Camera: NIDEK AFC-230
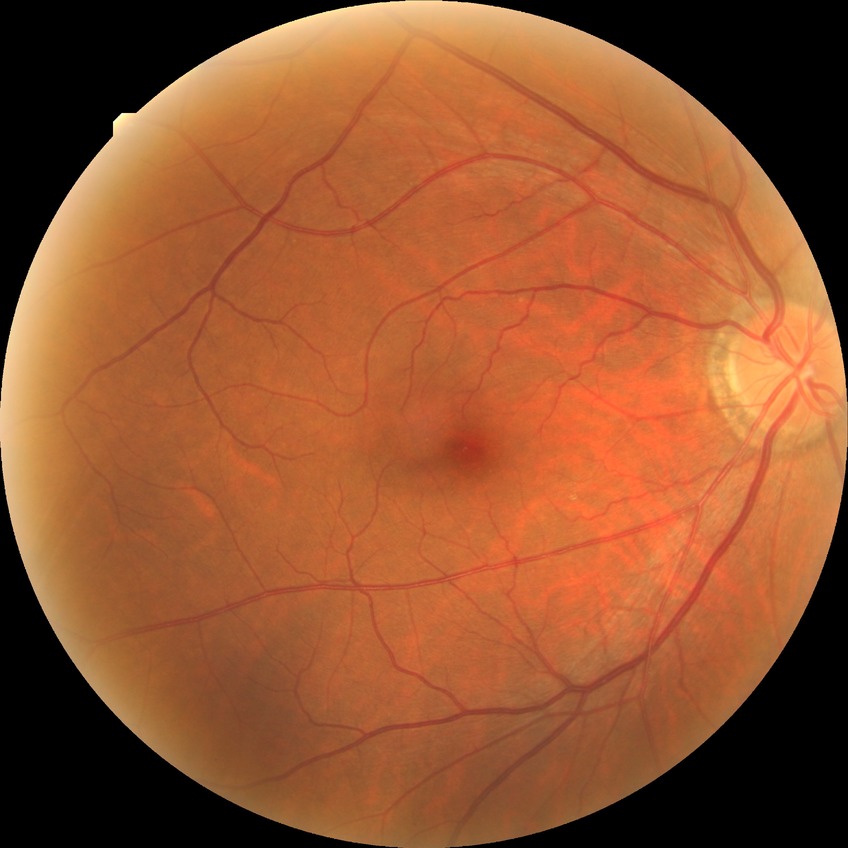

Davis grade is NDR.